2212 x 1659 pixels, retinal fundus photograph — 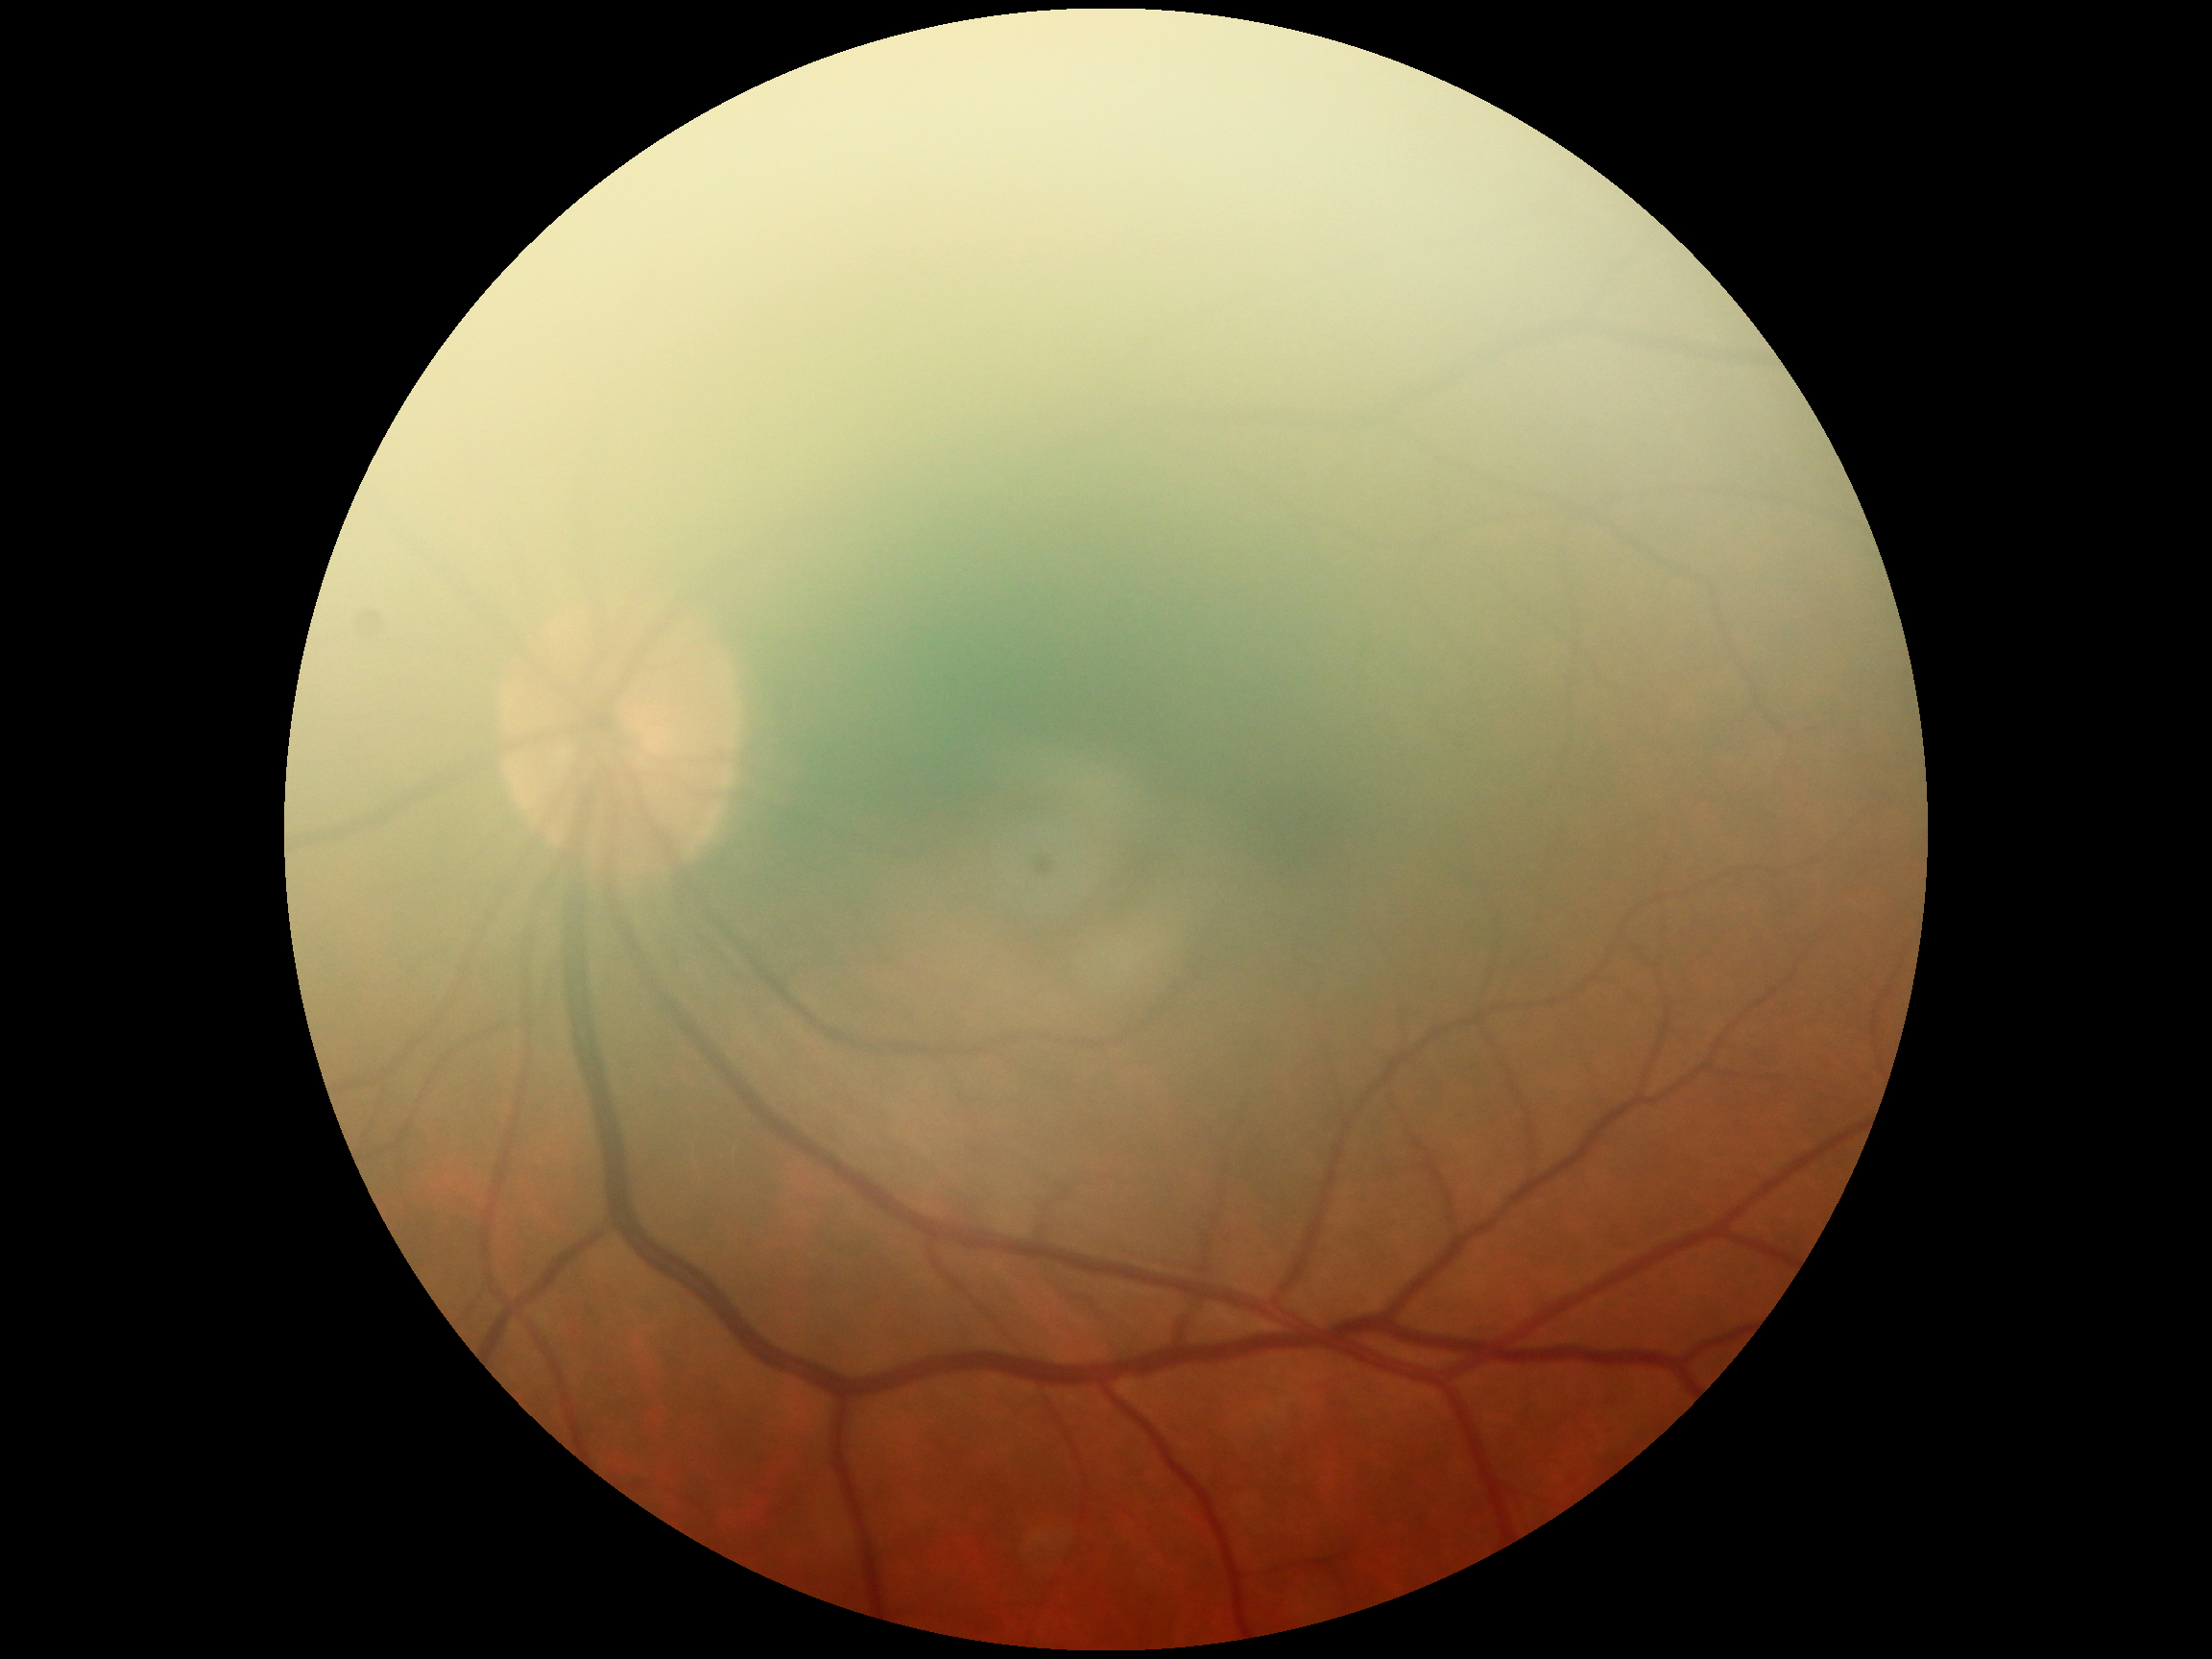
Diabetic retinopathy is no apparent retinopathy (grade 0).